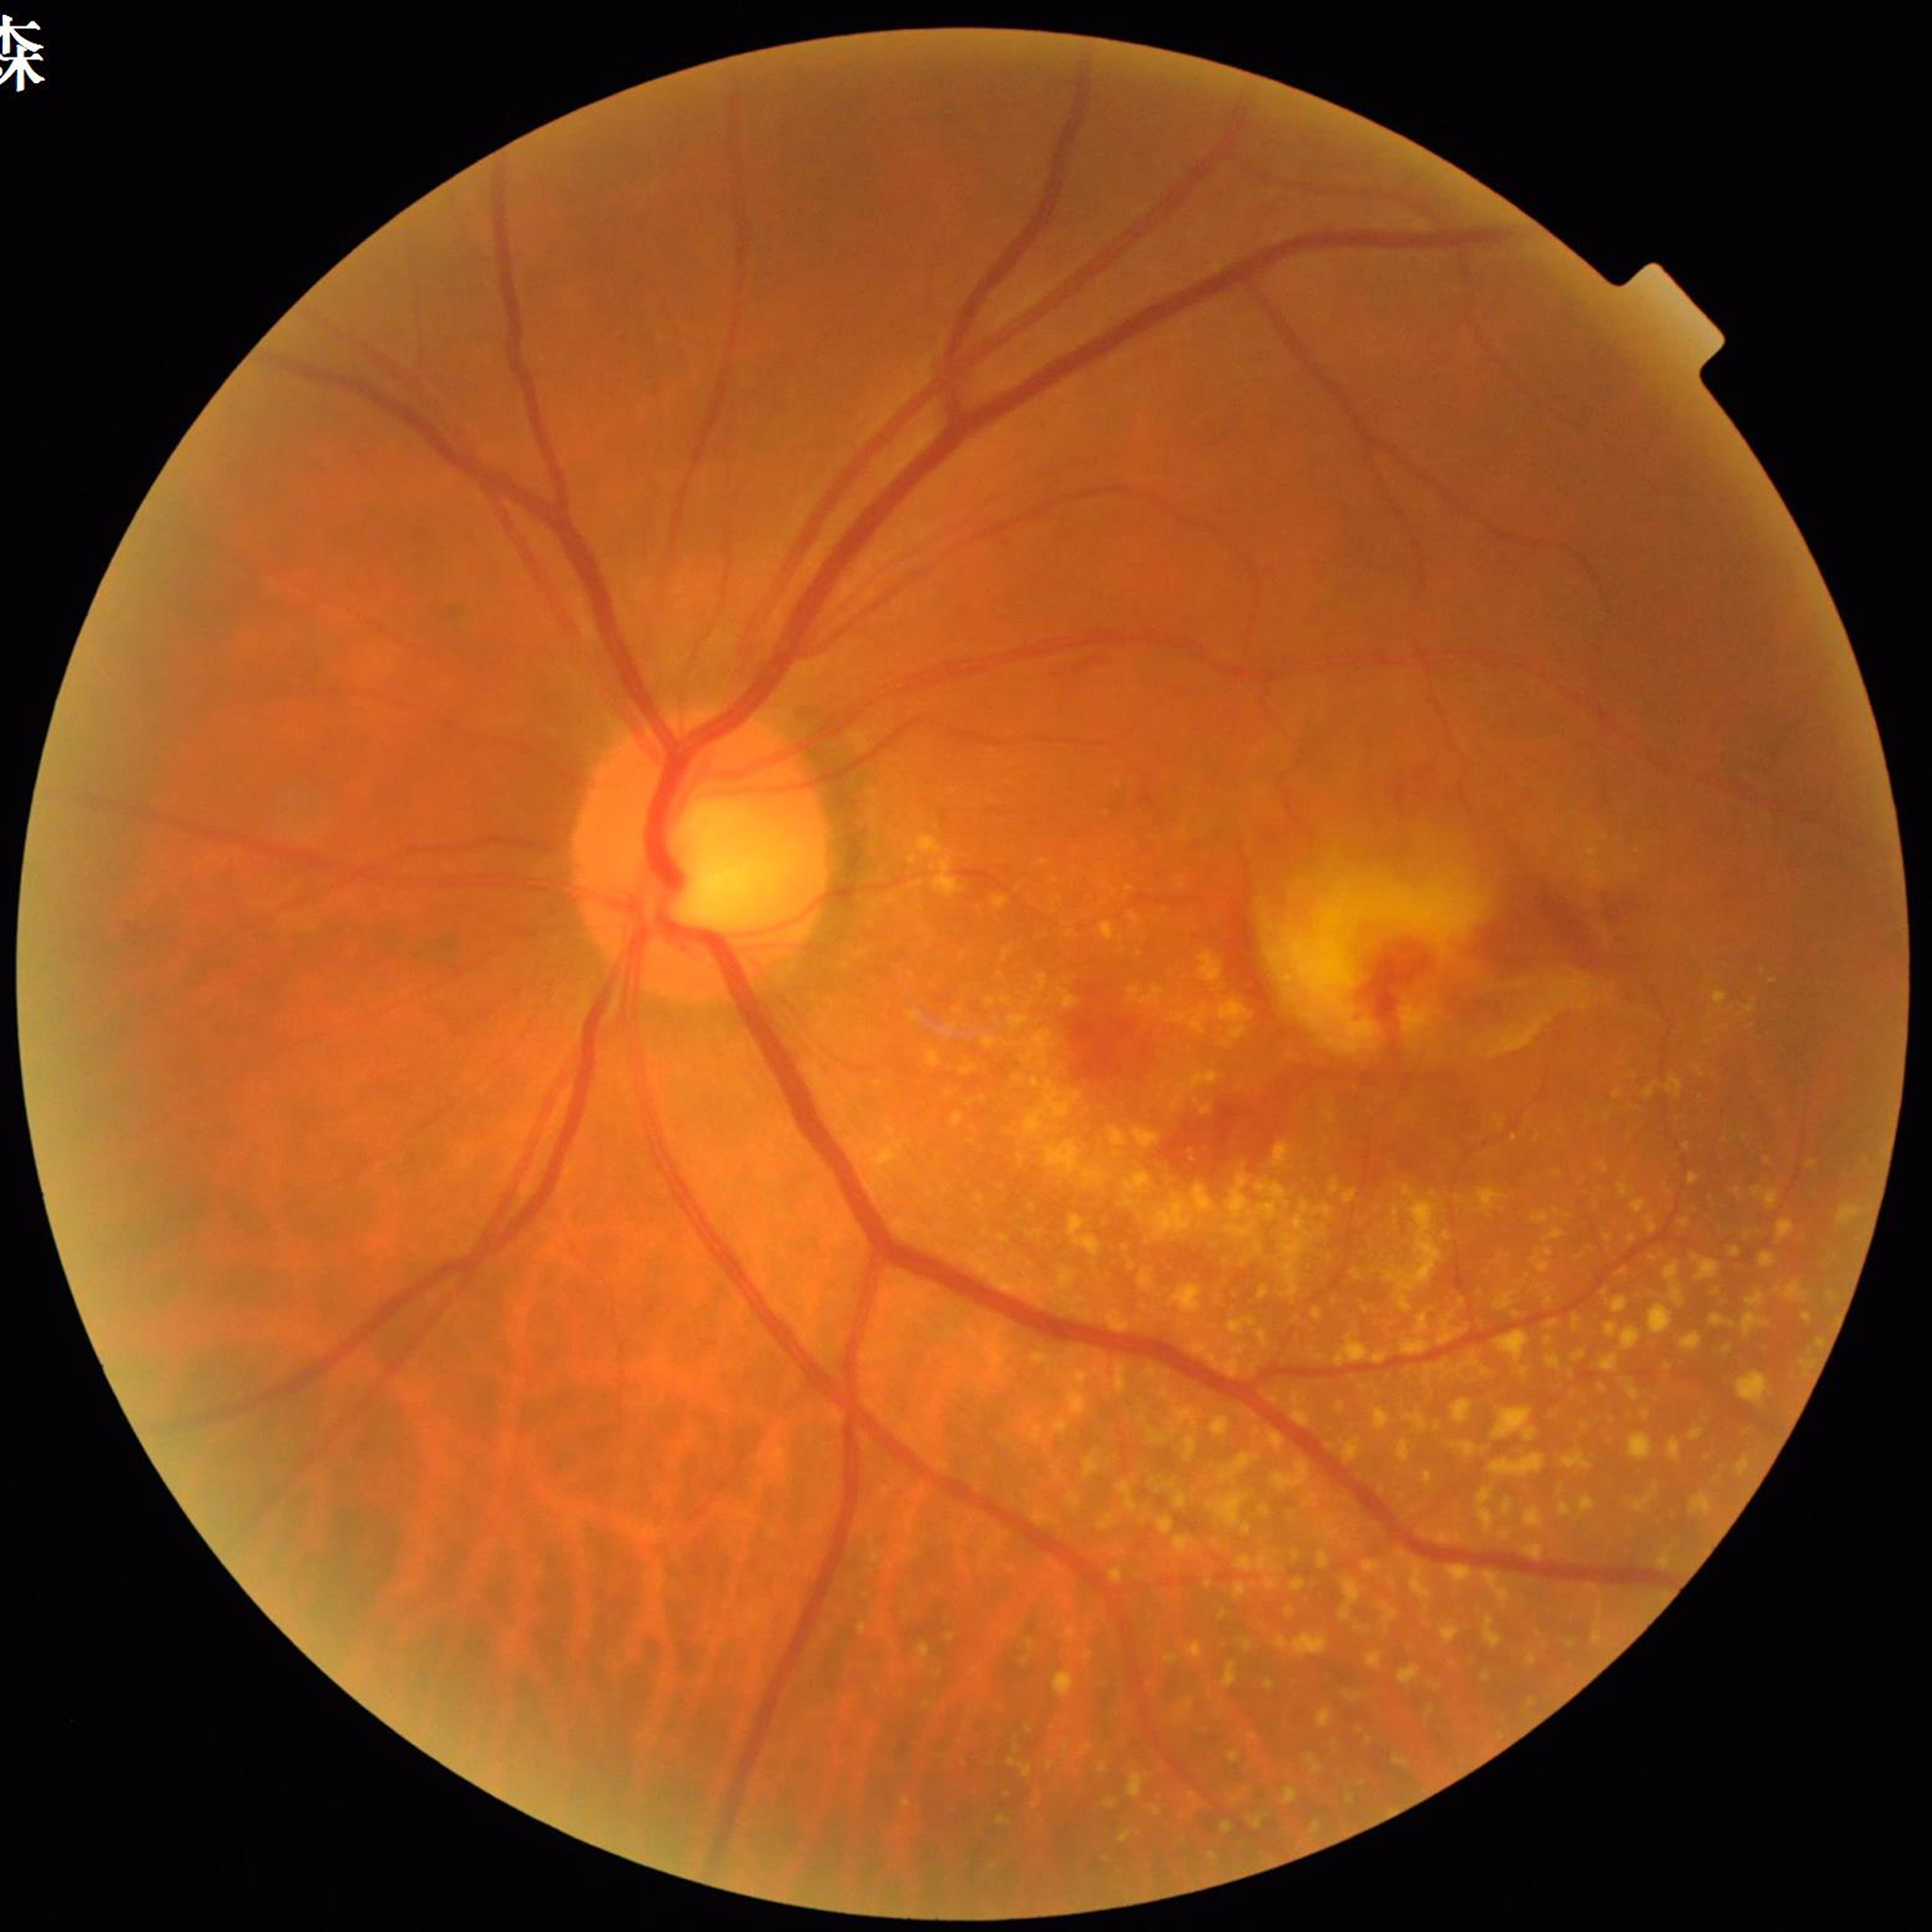

Automated quality assessment: adequate. Diagnosed with age-related macular degeneration (AMD).